2212x1659; CFP; 45° FOV.
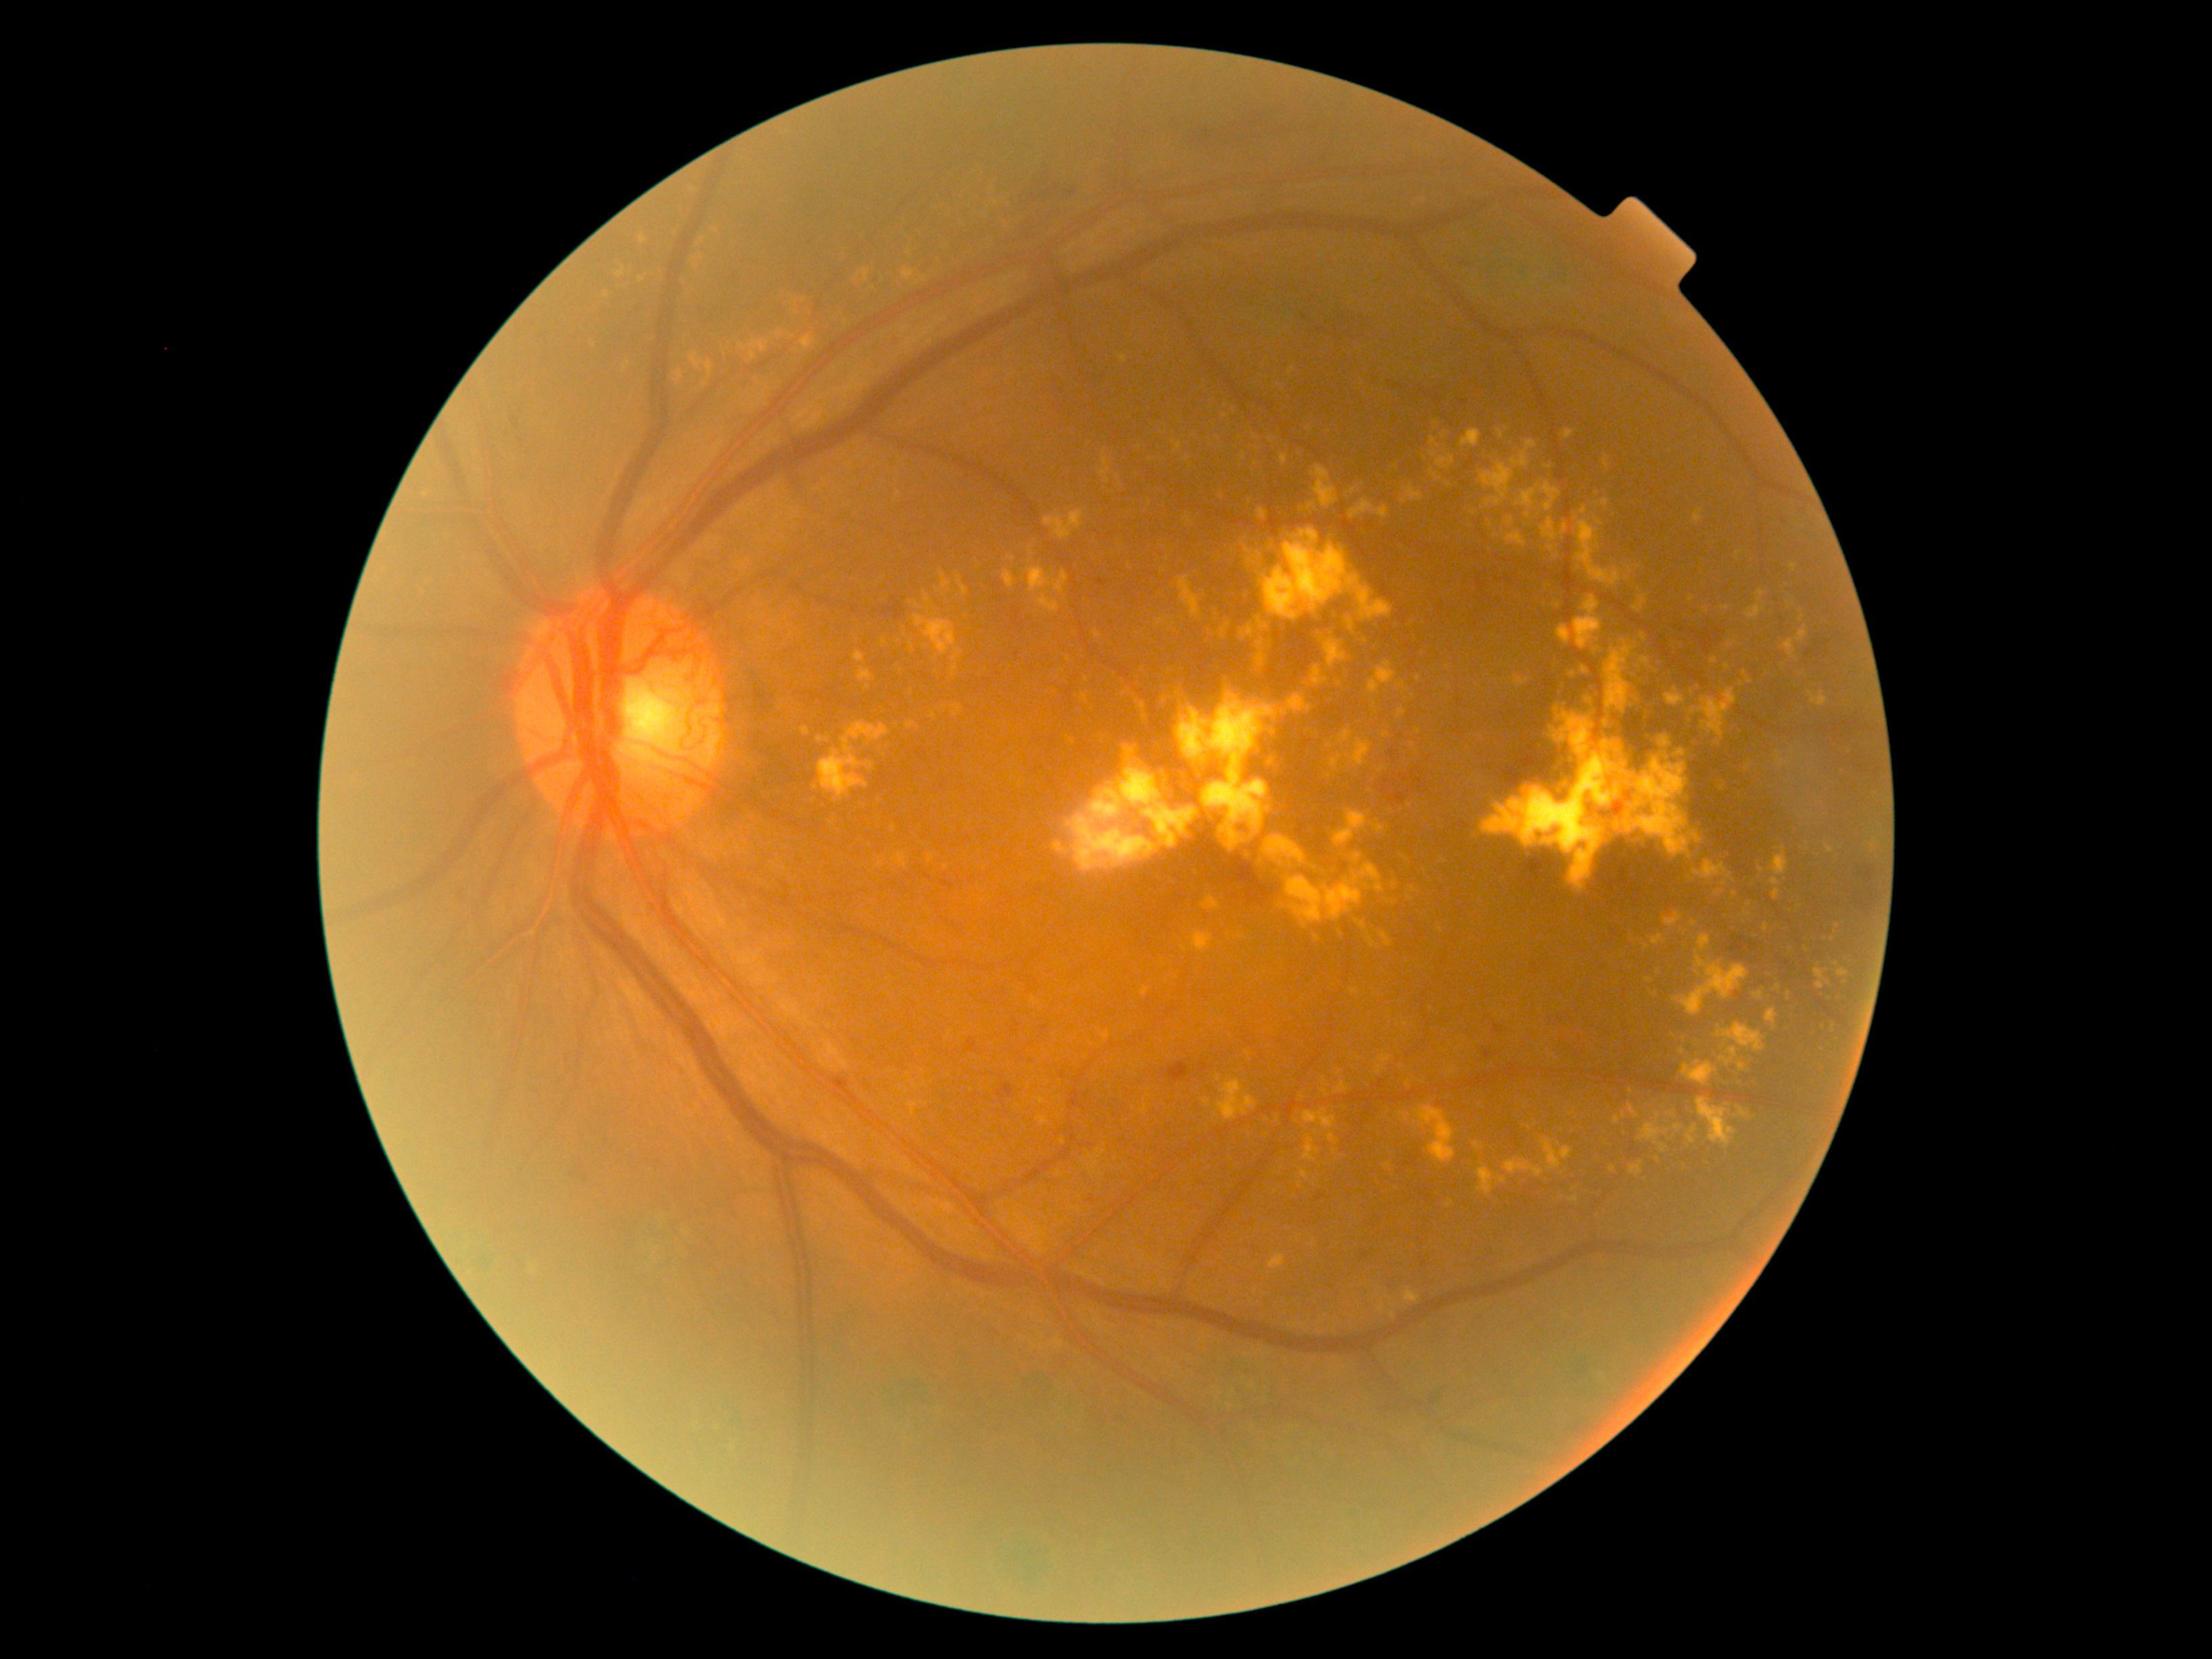
<lesions partial="true">
  <dr_grade>4</dr_grade>
  <ex partial="true">[left=951, top=651, right=963, bottom=677], [left=859, top=668, right=874, bottom=682], [left=1623, top=749, right=1703, bottom=859], [left=1585, top=697, right=1593, bottom=703], [left=1345, top=615, right=1353, bottom=630], [left=1028, top=567, right=1070, bottom=596], [left=1386, top=1295, right=1394, bottom=1302], [left=640, top=235, right=647, bottom=245], [left=1496, top=429, right=1504, bottom=438], [left=817, top=737, right=830, bottom=743], [left=1771, top=846, right=1788, bottom=876], [left=691, top=354, right=701, bottom=369]</ex>
  <ex_small_centers><pt>816,788</pt>, <pt>1413,745</pt>, <pt>1398,469</pt>, <pt>1303,1099</pt>, <pt>1875,843</pt>, <pt>1029,1087</pt>, <pt>1239,936</pt>, <pt>1229,935</pt></ex_small_centers>
</lesions>